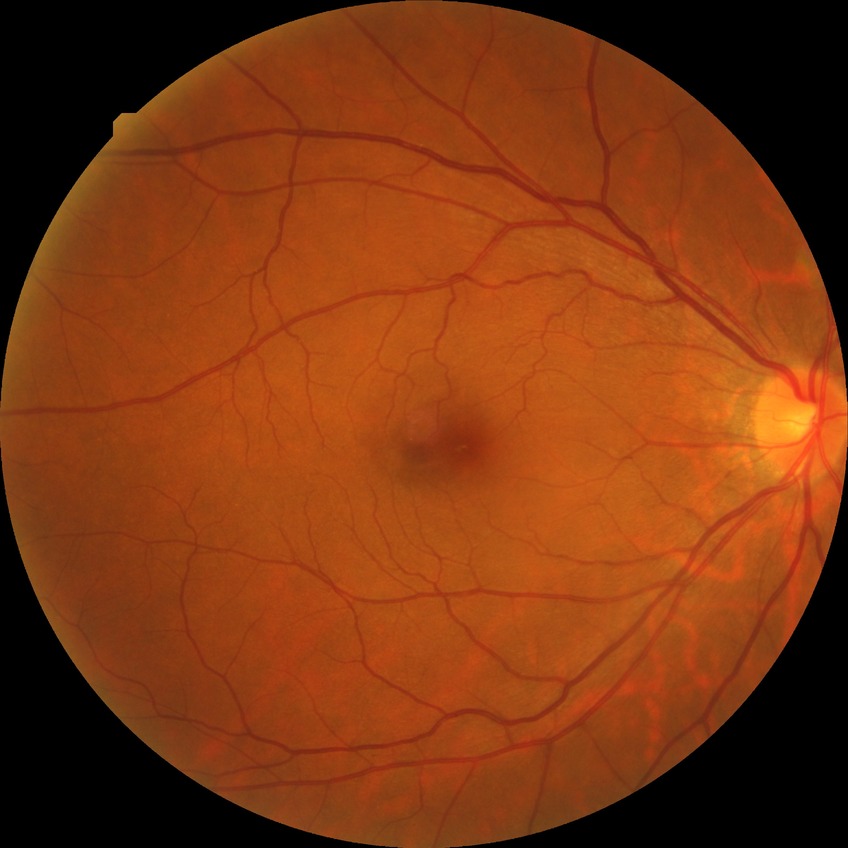 diabetic retinopathy (DR)=no diabetic retinopathy (NDR).